Fundus photo, 2352x1568, 45-degree field of view
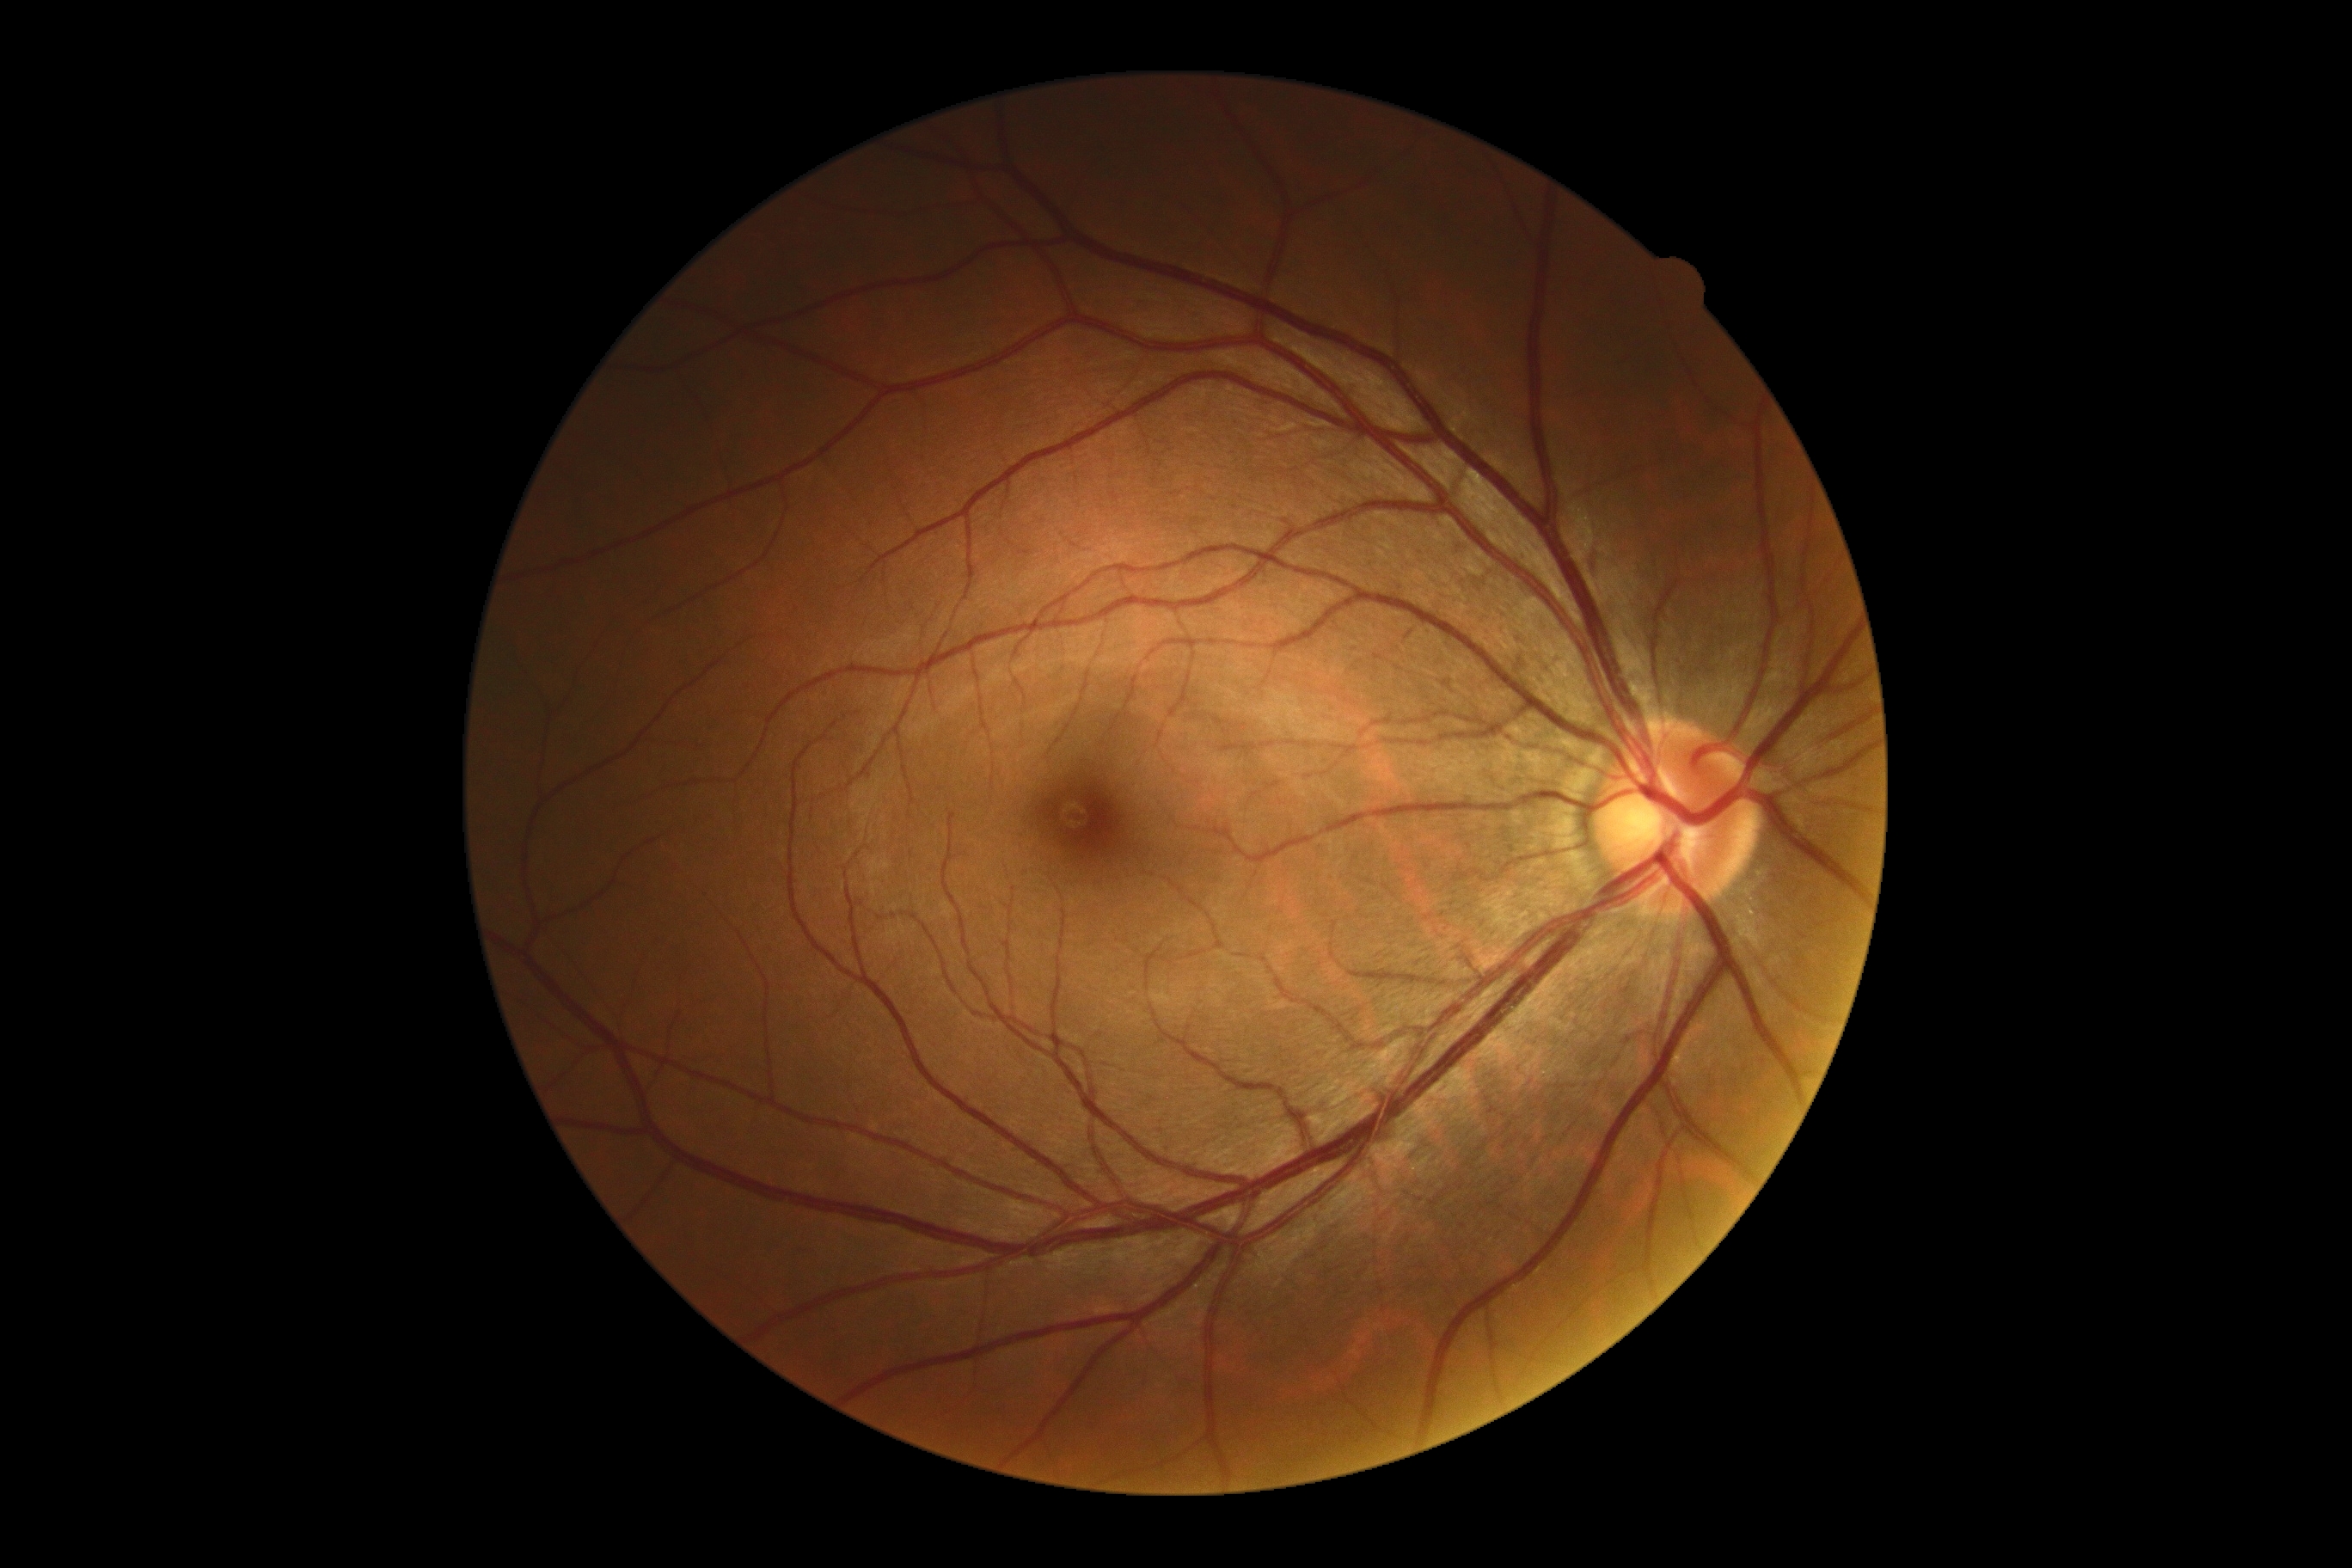
dr_grade: 0/4